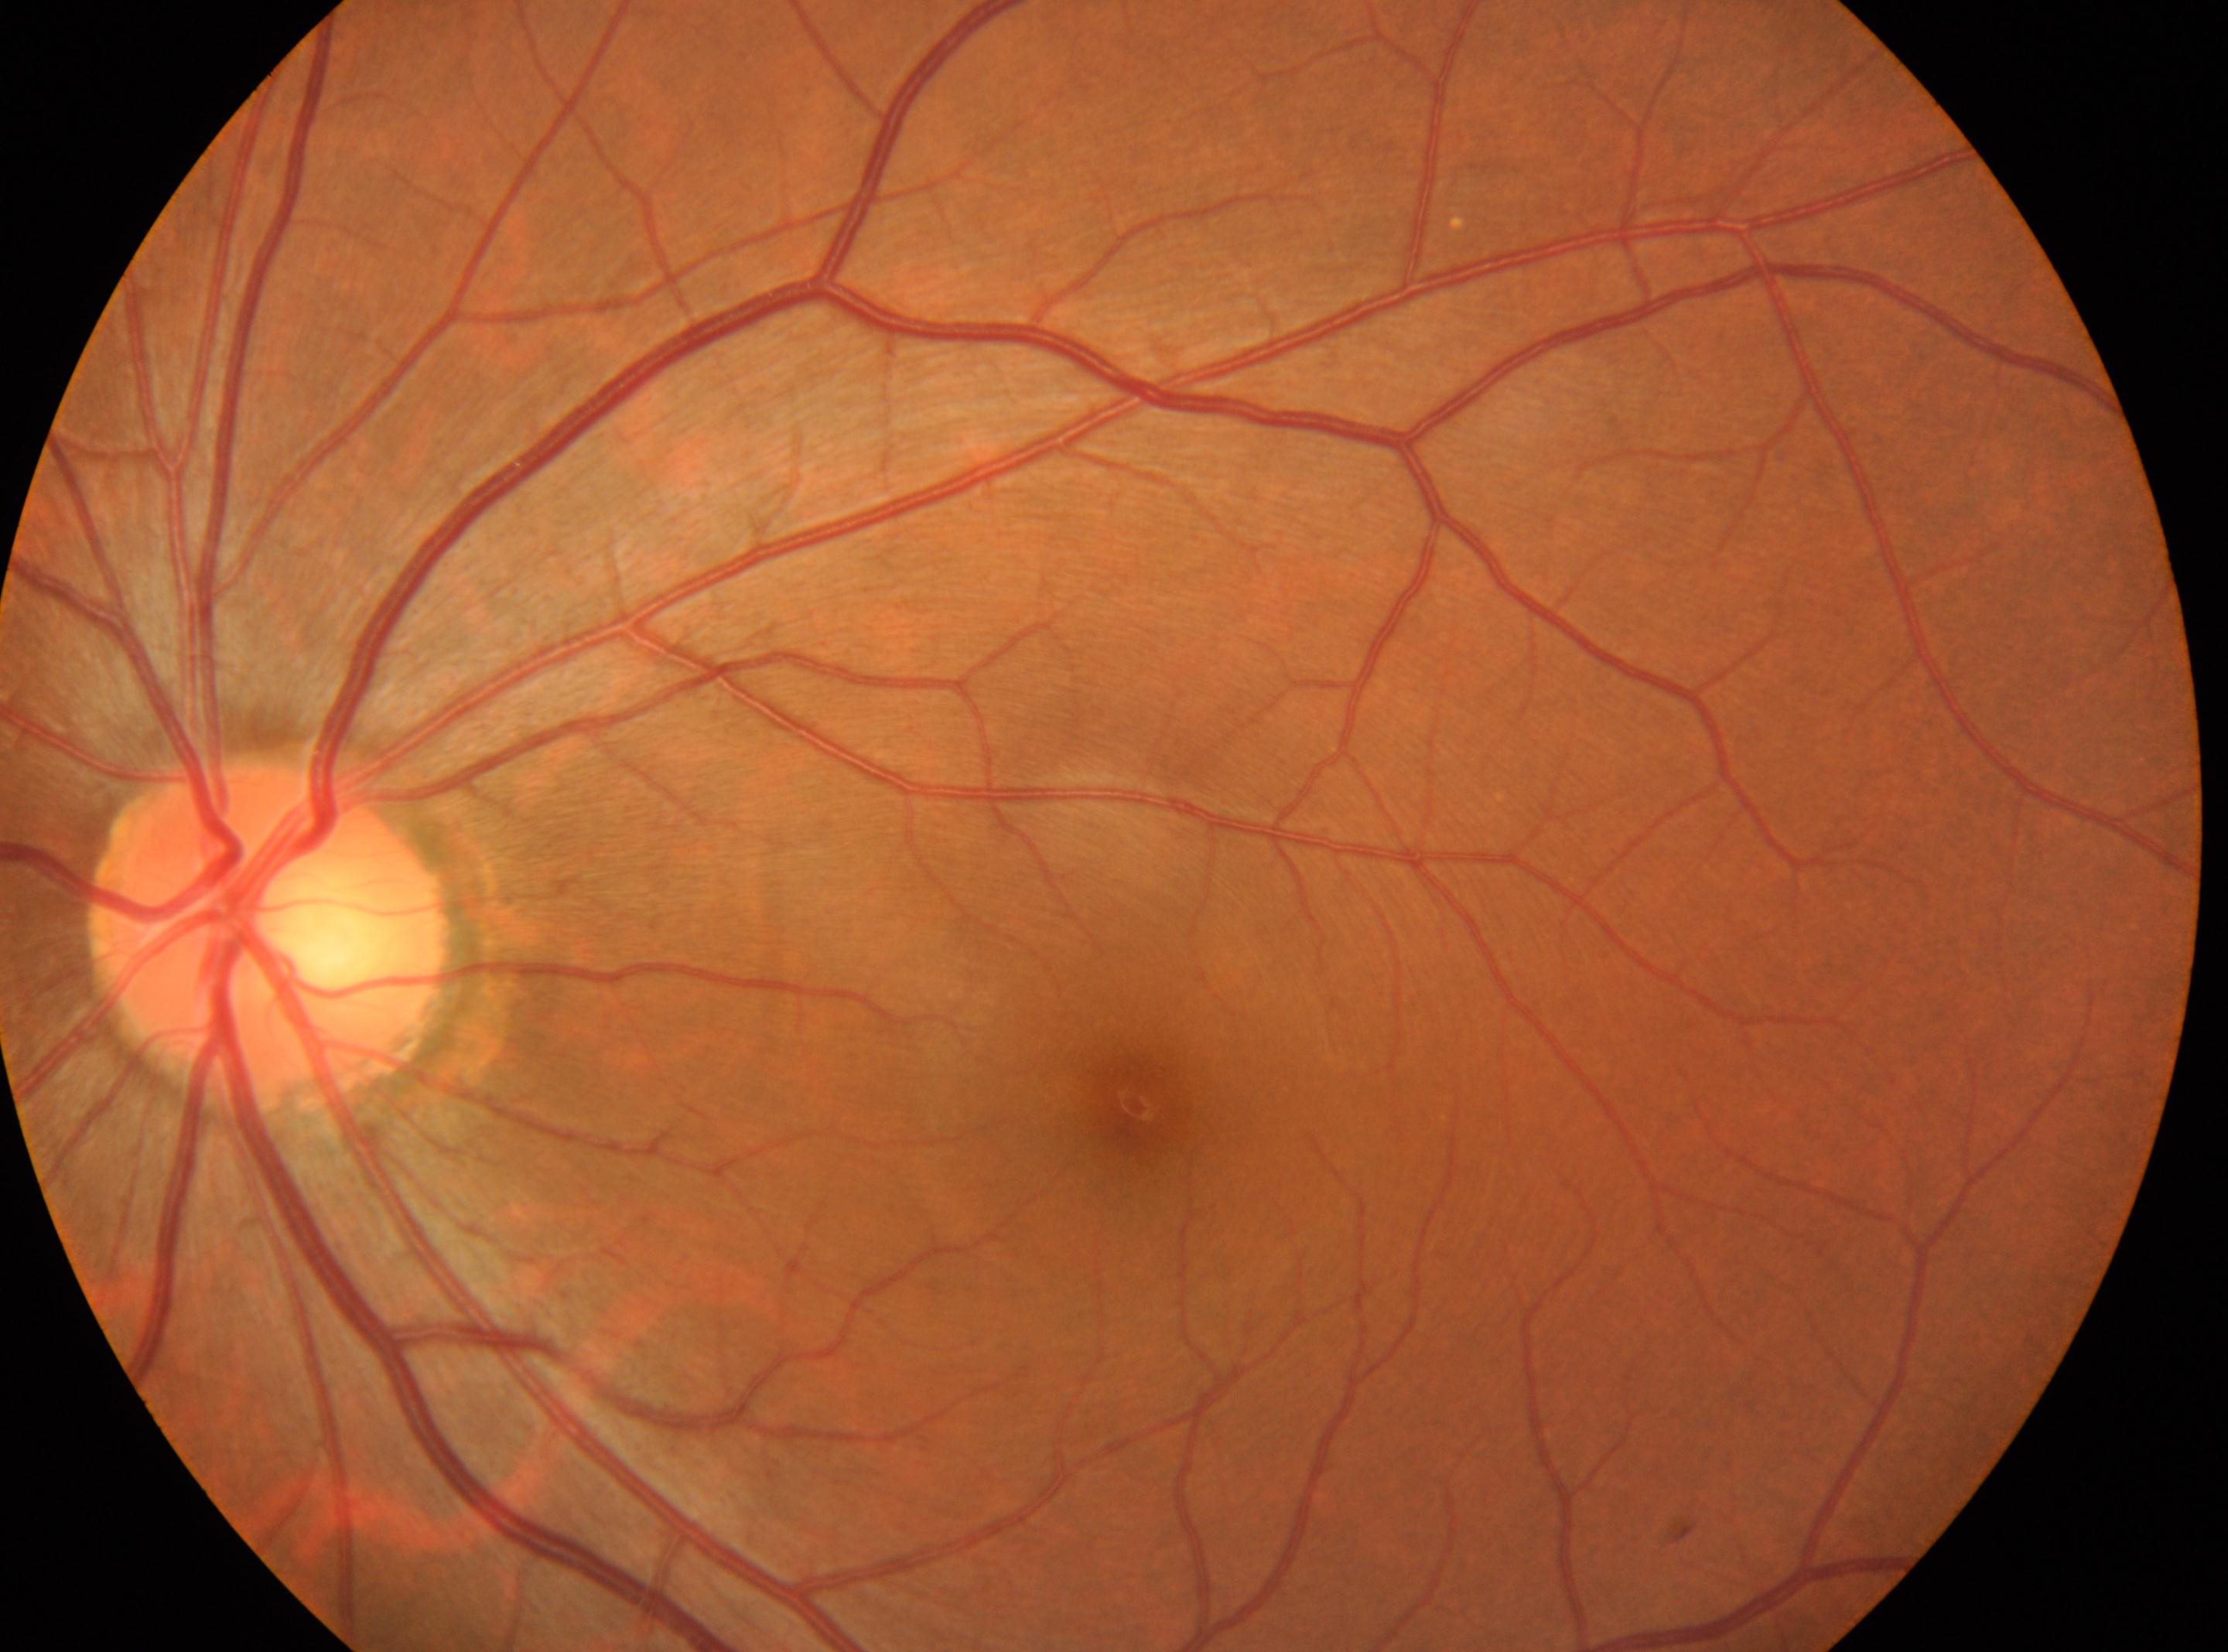 This is the oculus sinister. Macular center located at x=1134, y=1103. ONH located at x=269, y=935. Diabetic retinopathy (DR) is no apparent retinopathy (grade 0) — no visible signs of diabetic retinopathy. No DR findings.